Mydriatic (tropicamide and phenylephrine), 50° FOV, 2228x1652 — 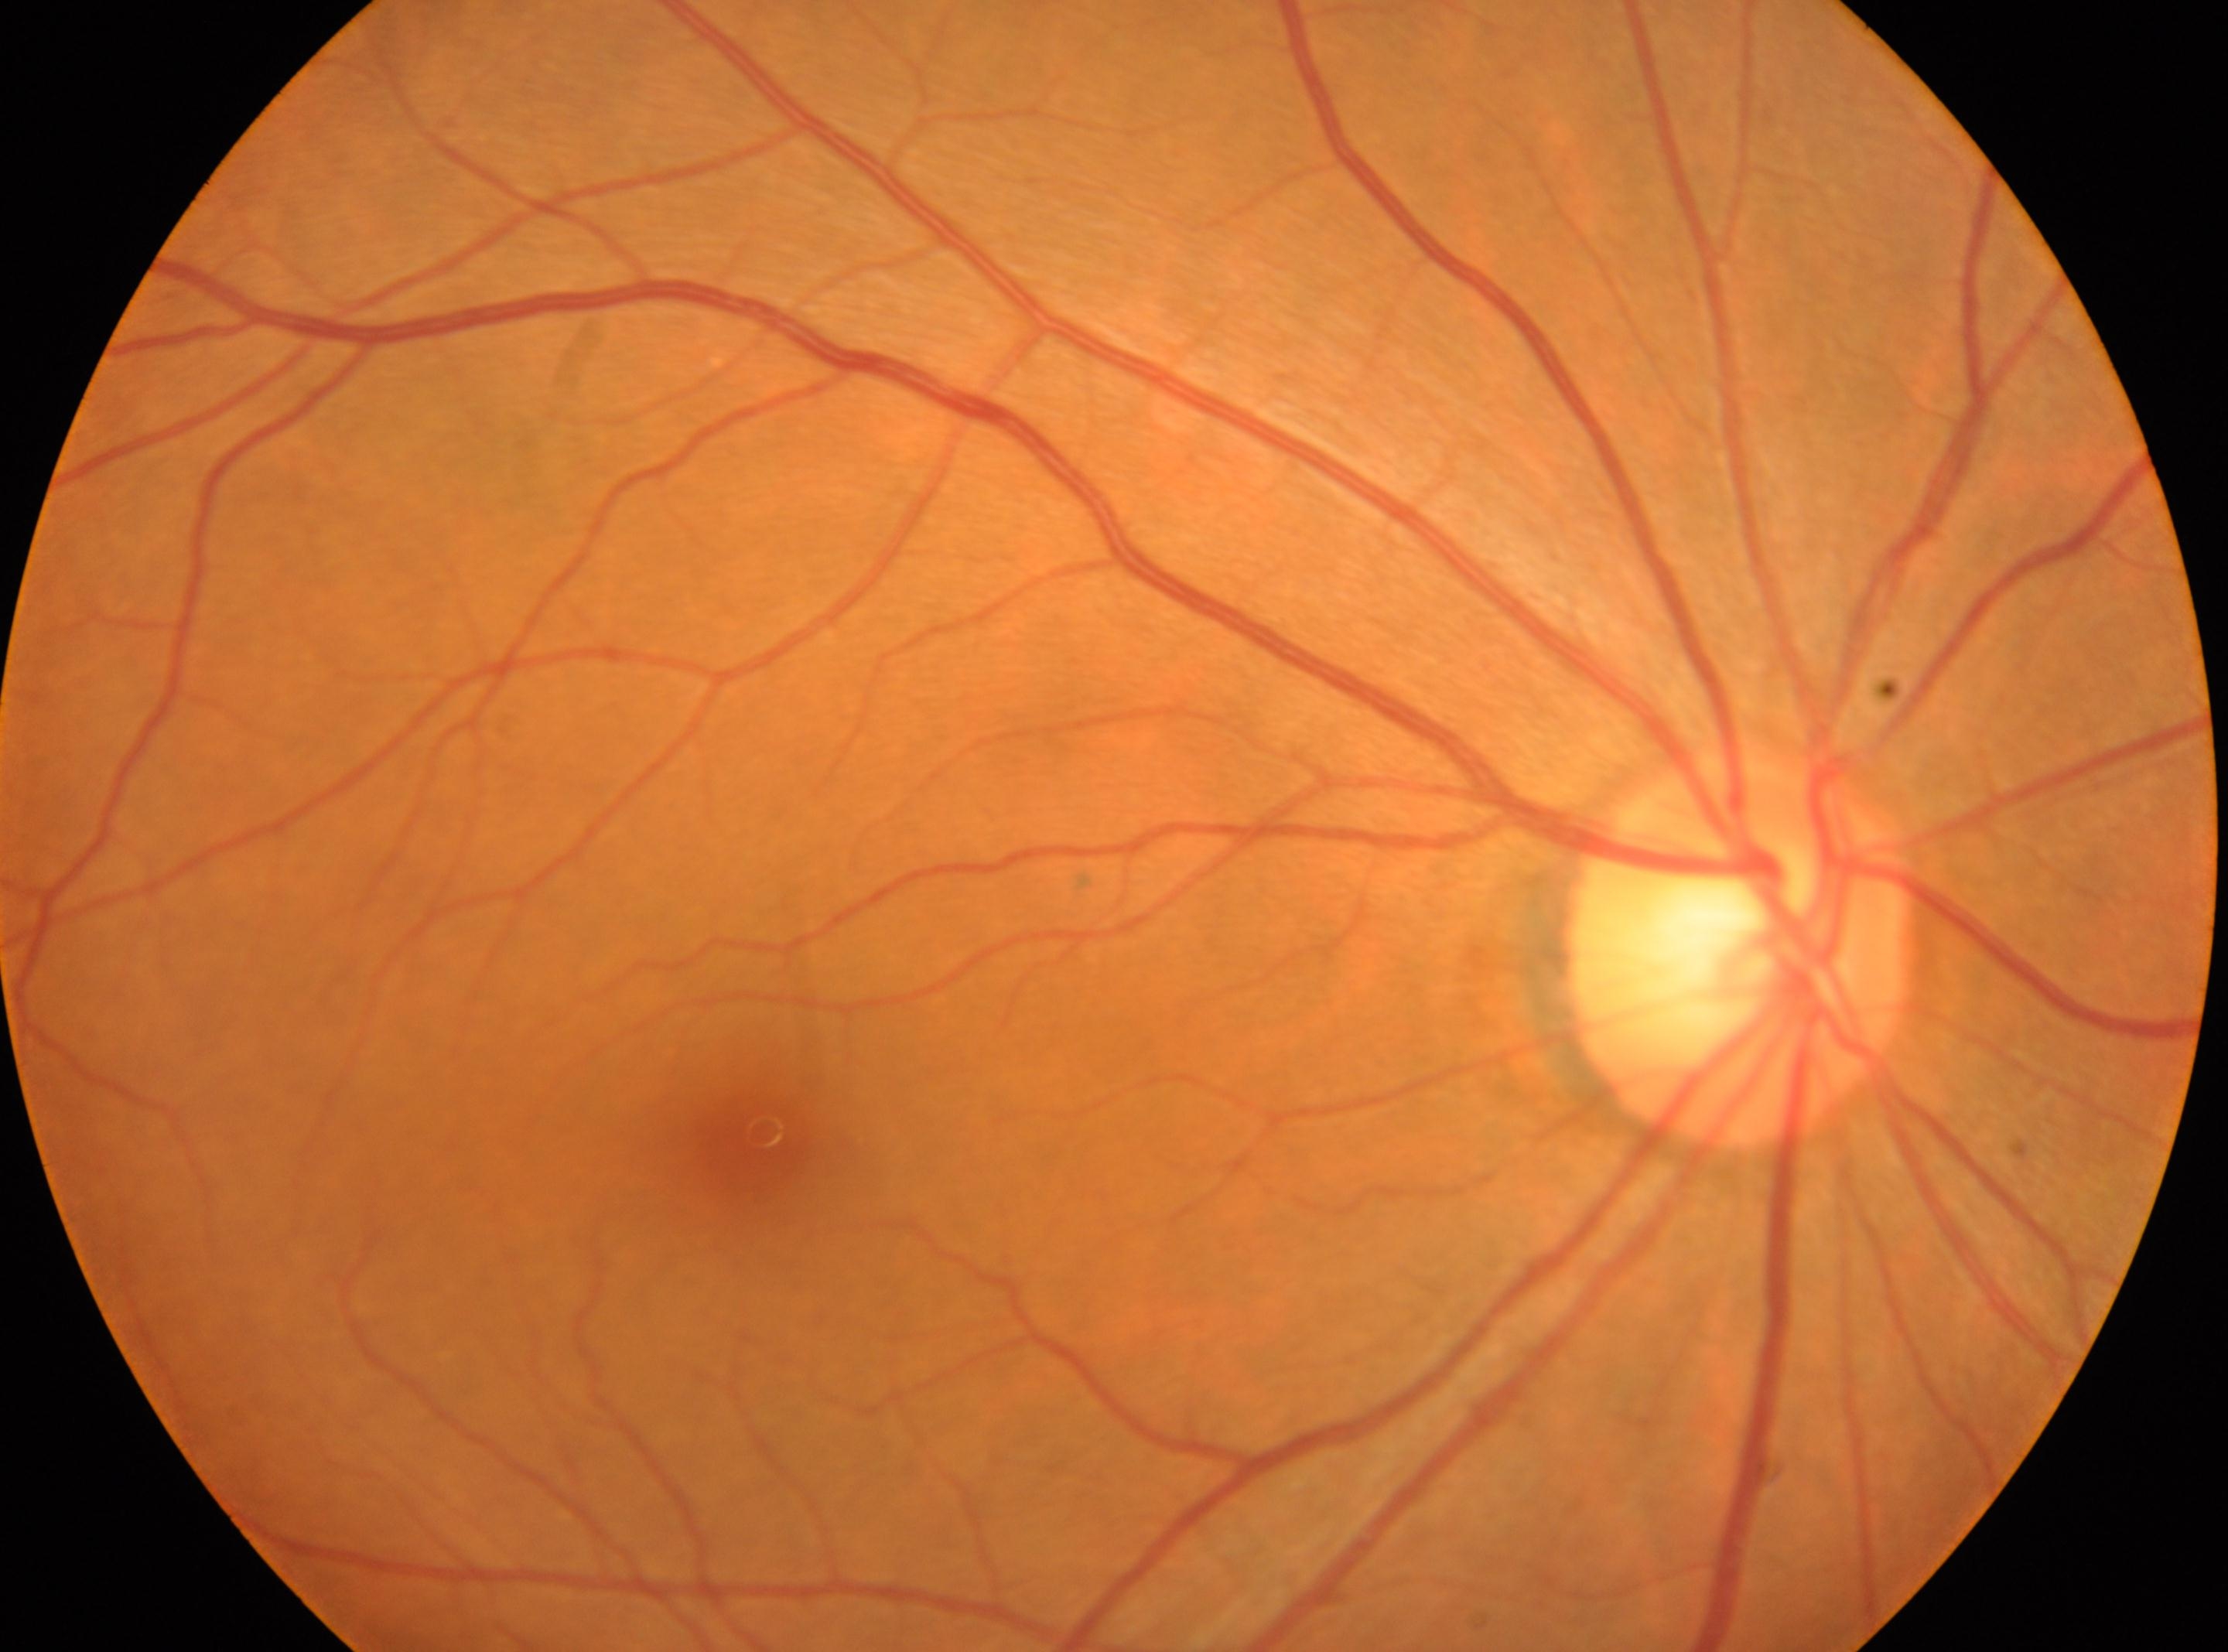

Macular center located at (761, 1137).
ONH: (1735, 953).
No diabetic retinopathy identified.
Diabetic retinopathy (DR): grade 0 — no visible signs of diabetic retinopathy.
Imaged eye: oculus dexter.